Pediatric wide-field fundus photograph · image size 1240x1240 — 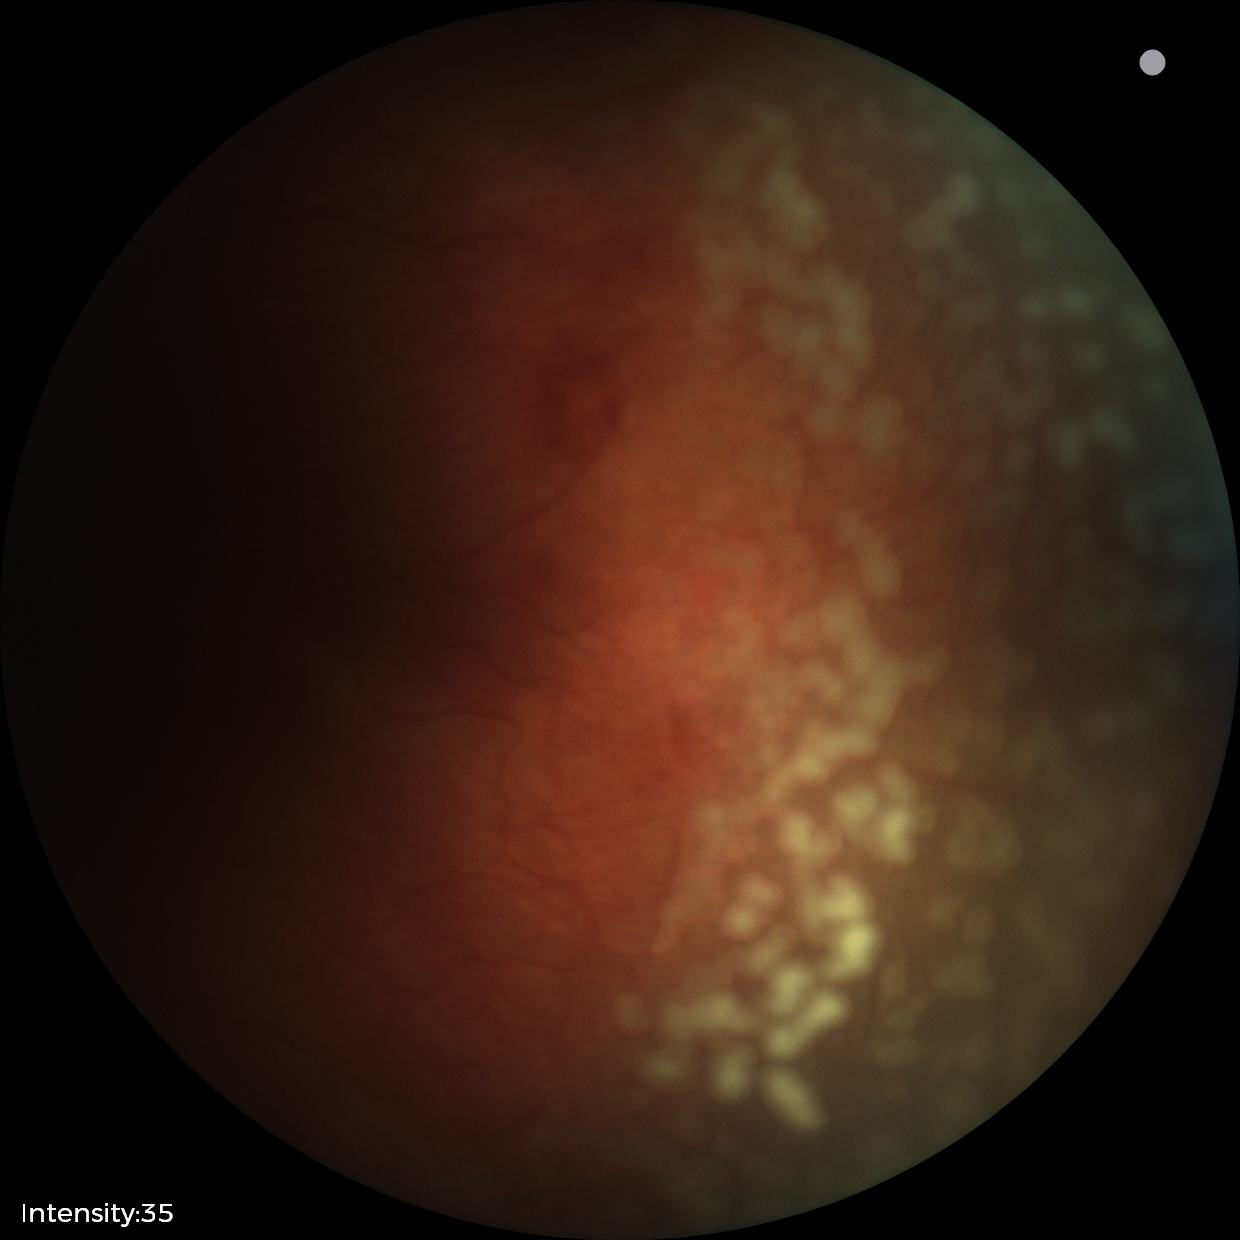

Screening series with retinopathy of prematurity (ROP) stage 2. Plus disease present.